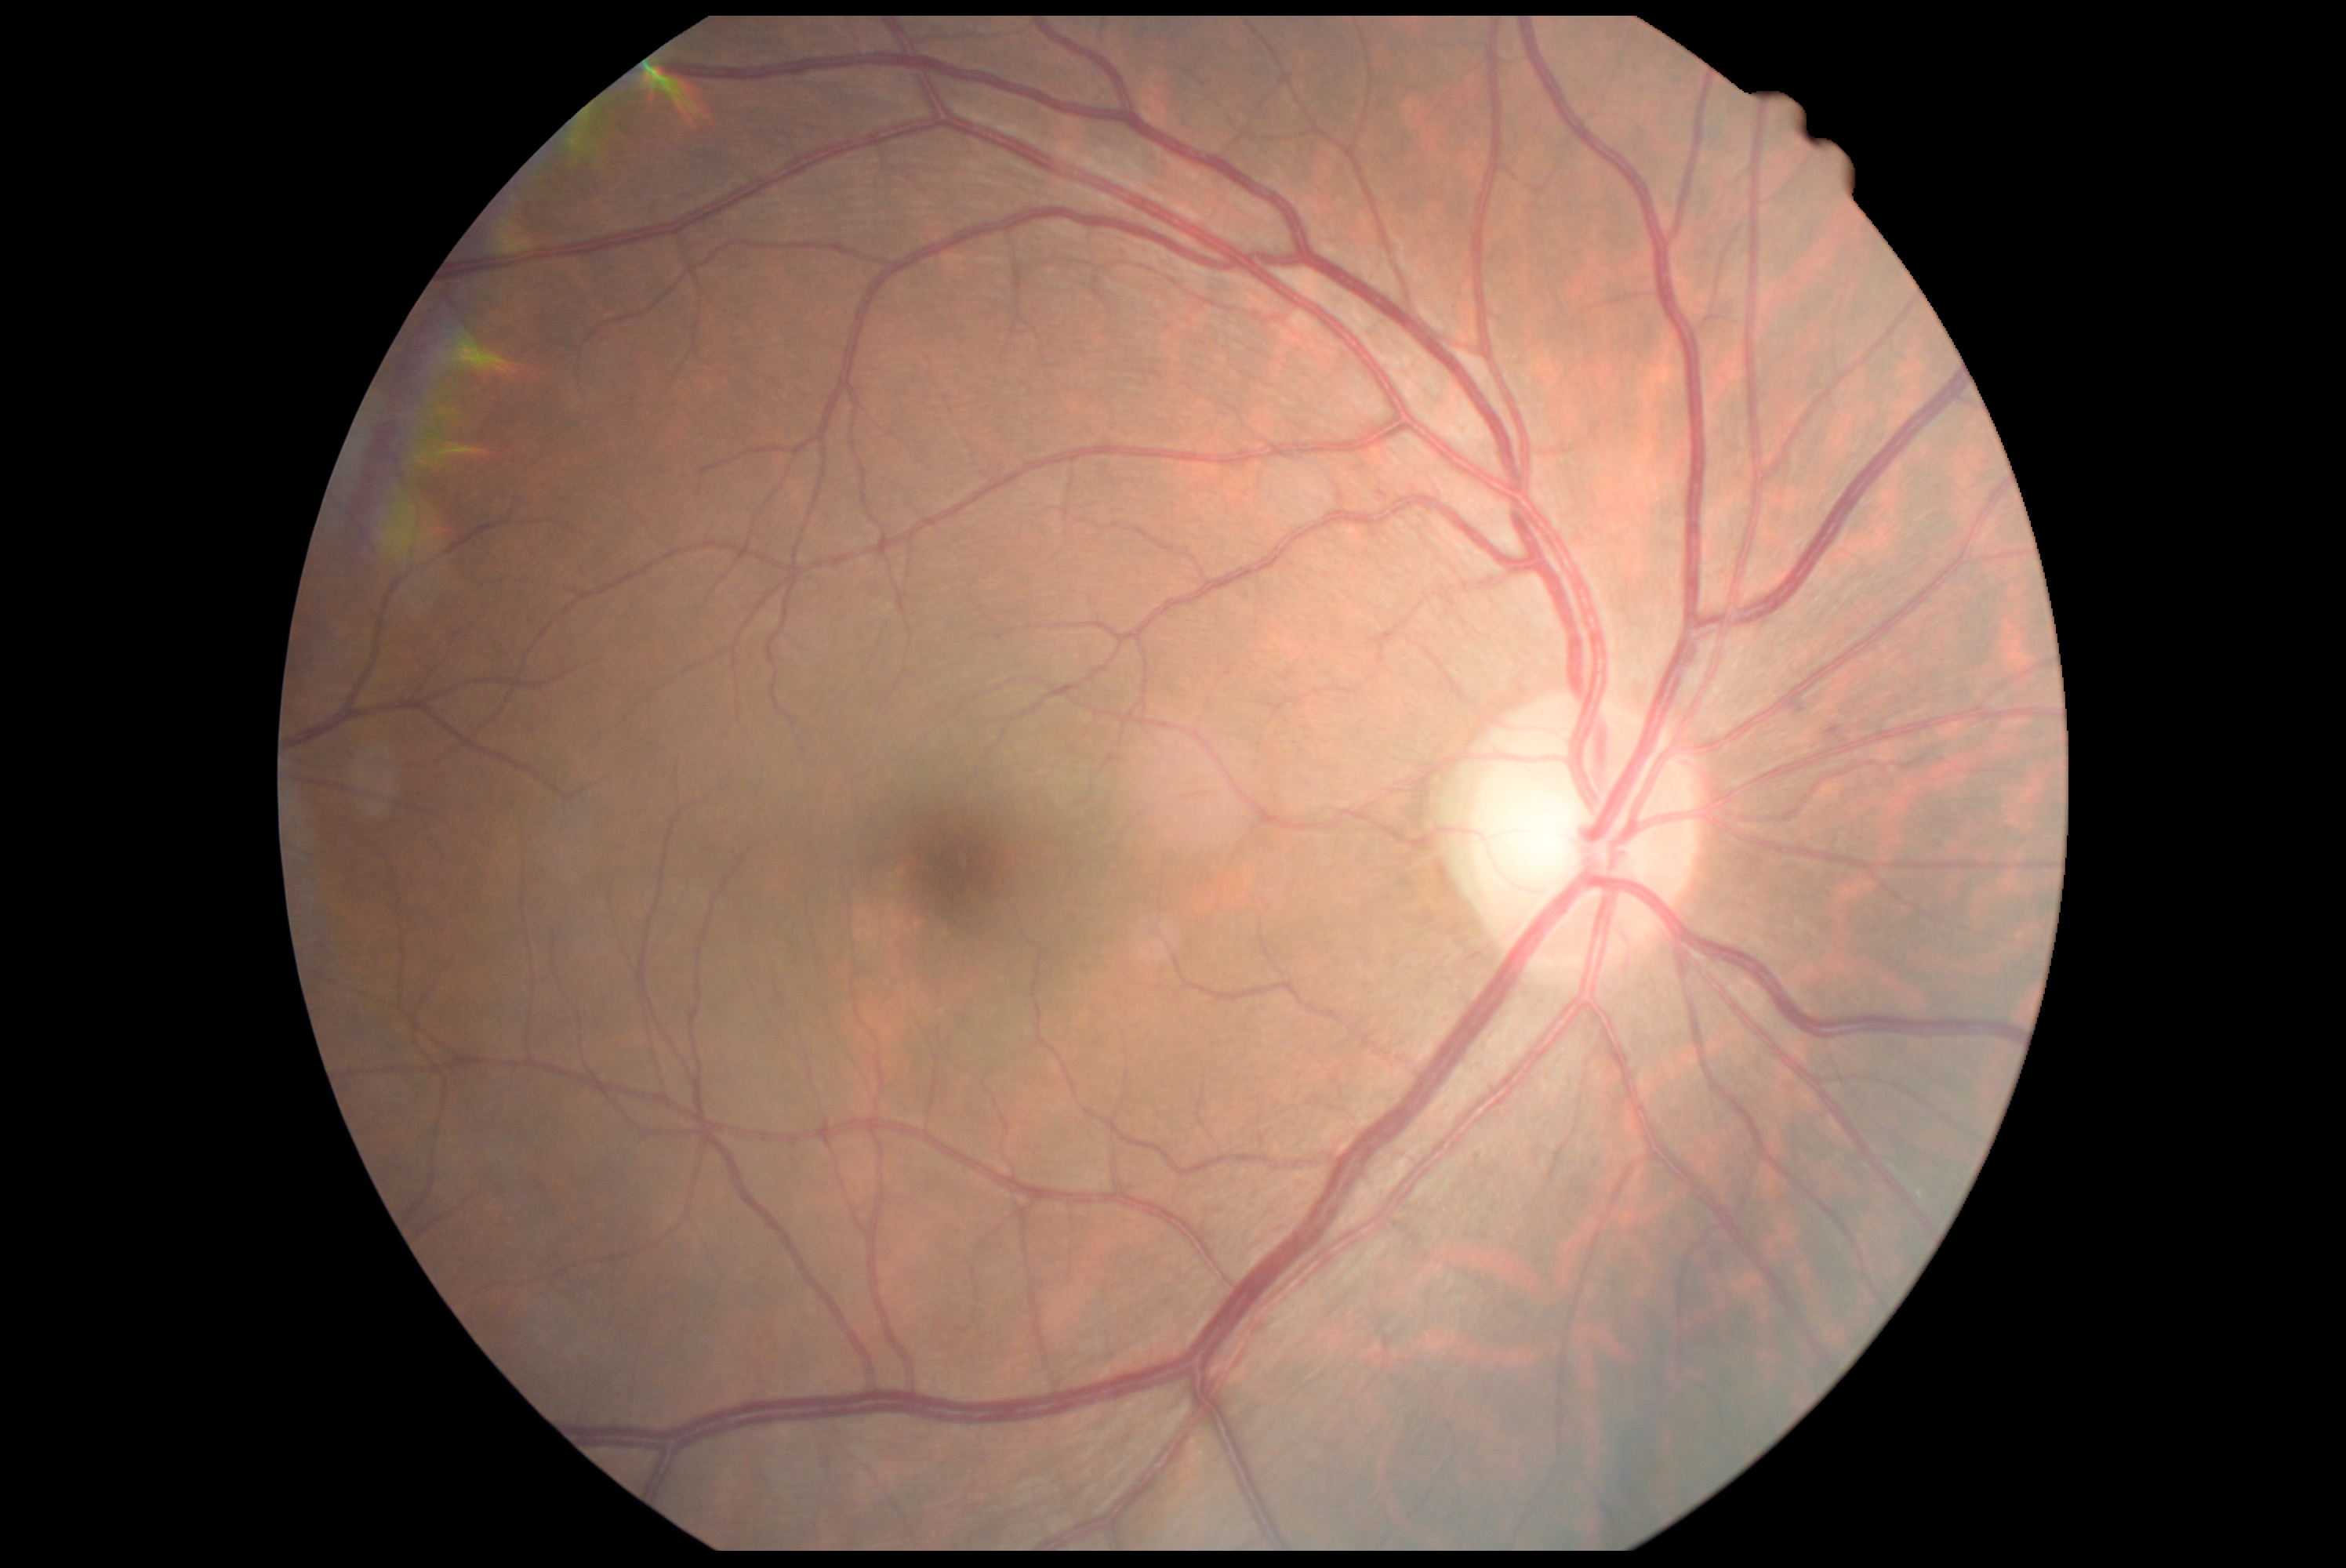
DR impression = no signs of DR
DR stage = 0/4